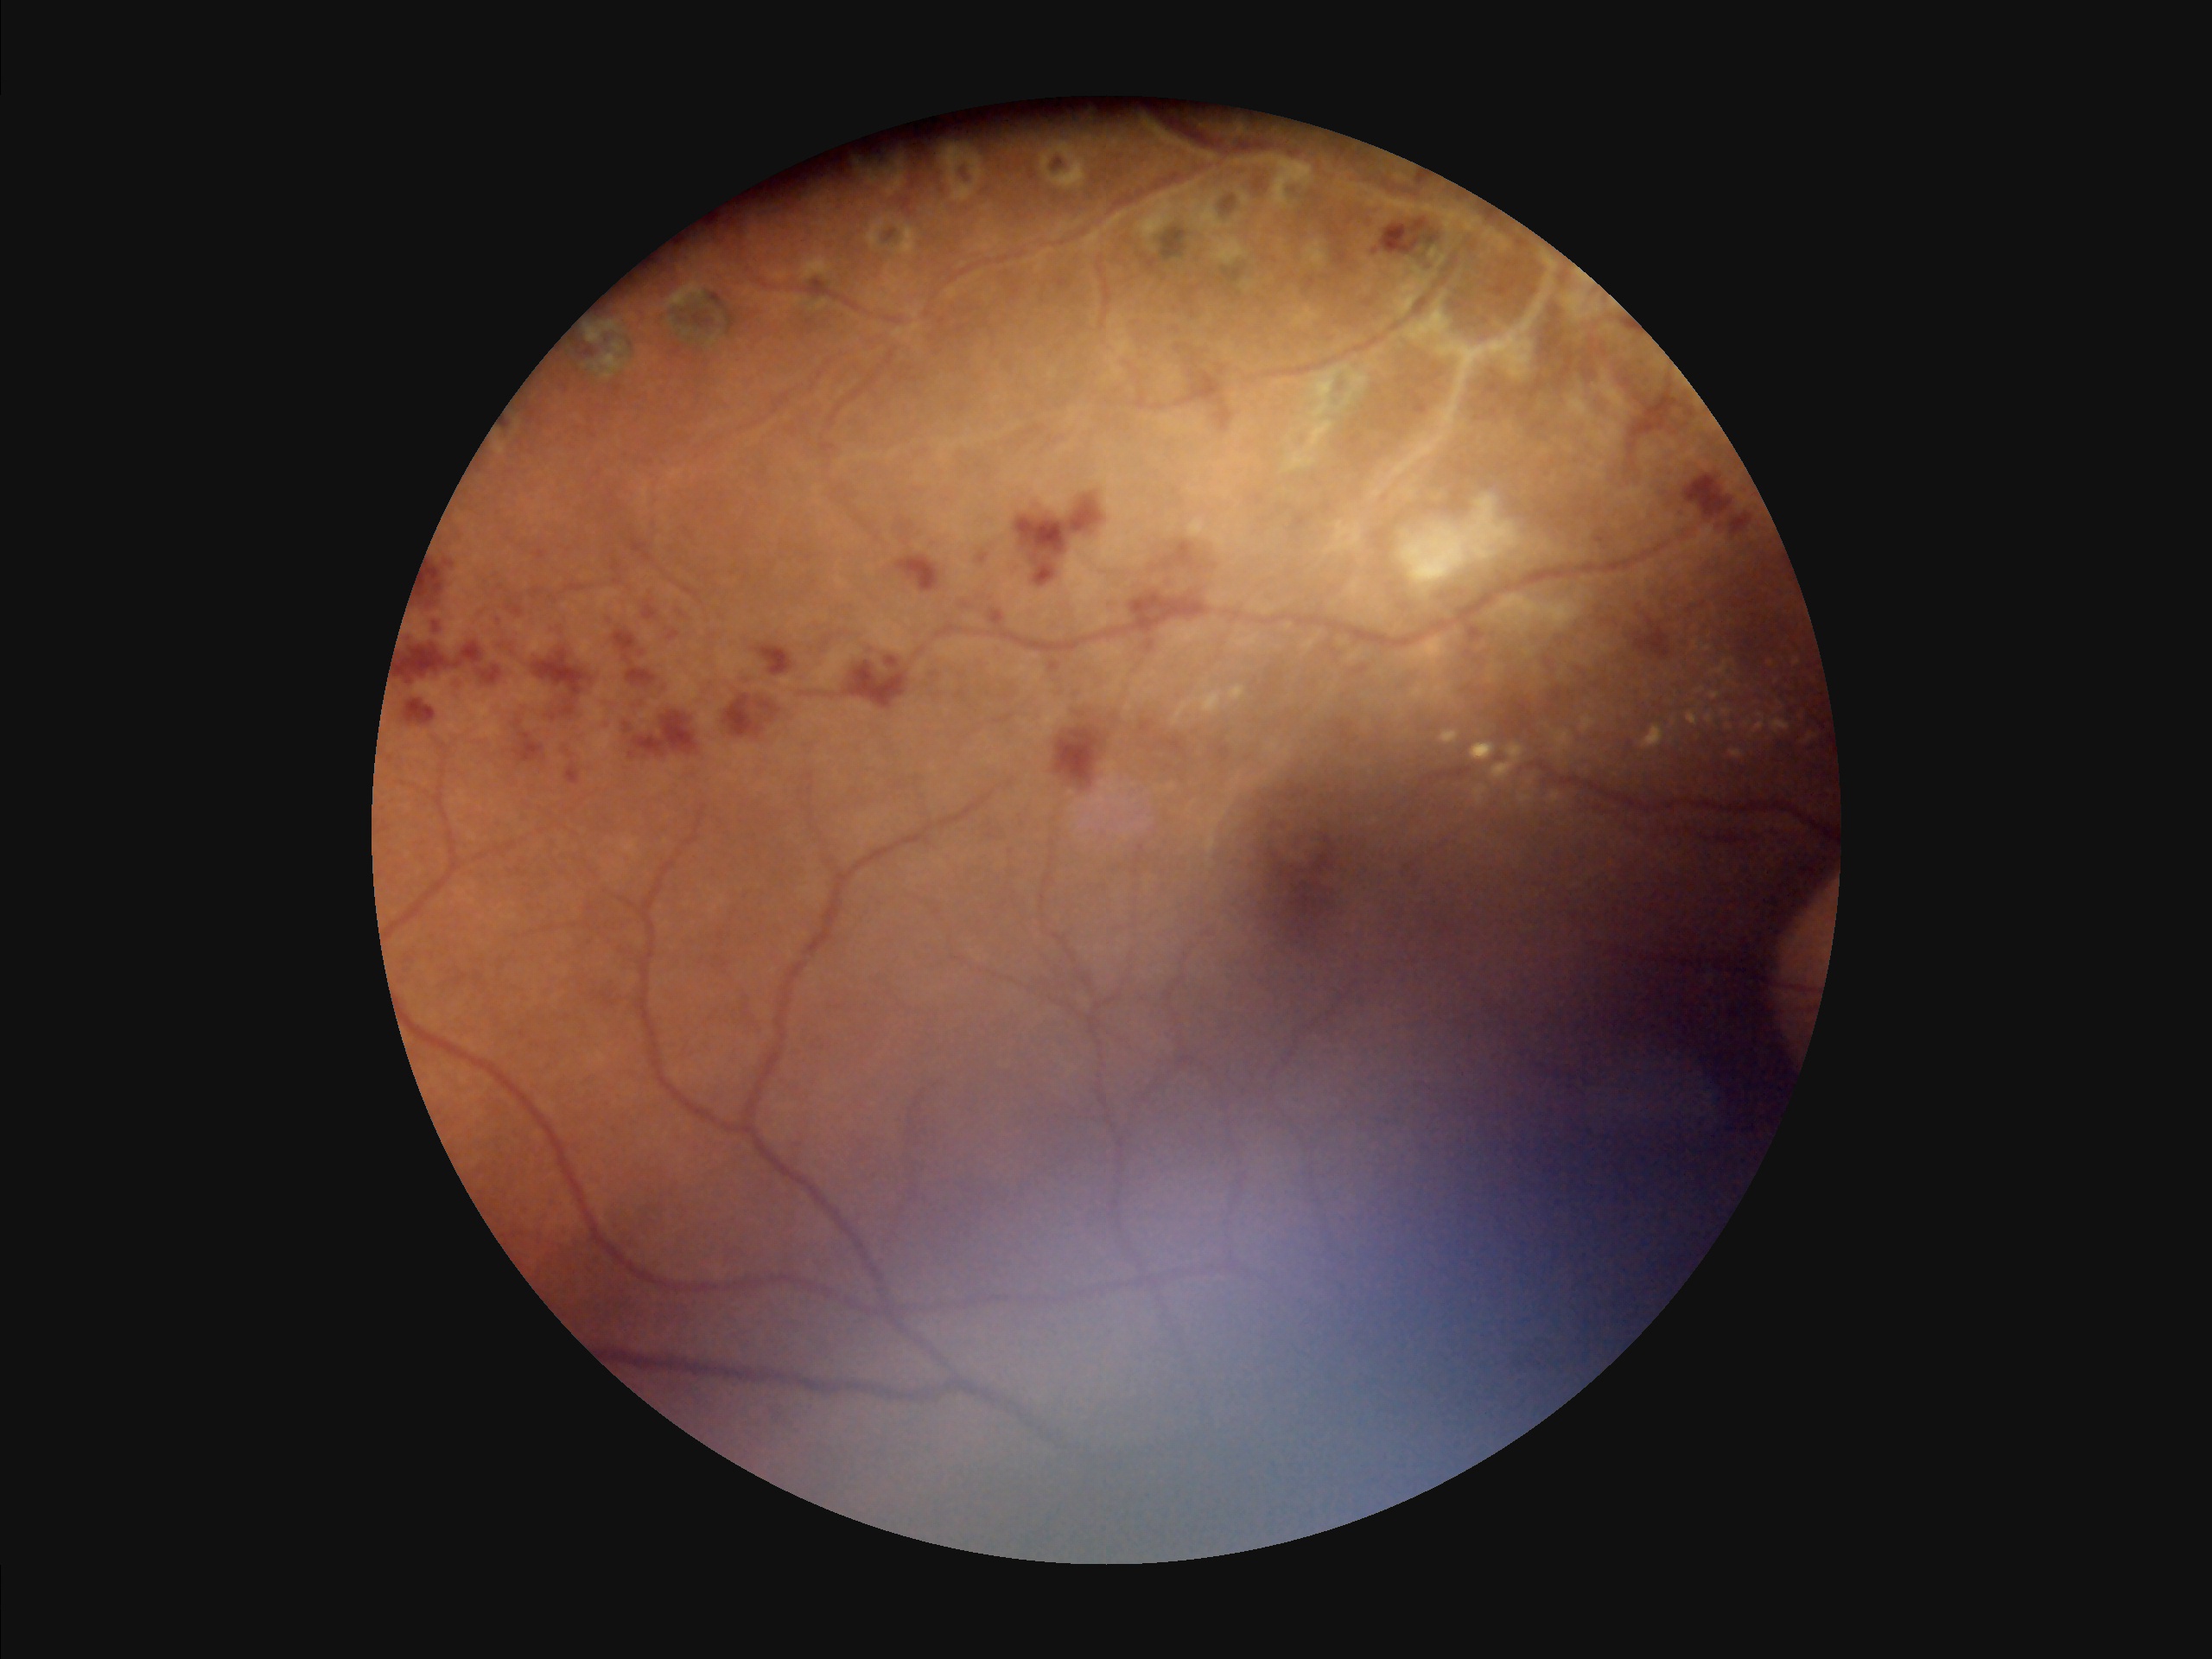

Illumination is uneven. Overall image quality is poor. Out of focus; structures are indistinct. Adequate contrast for distinguishing structures.